Modified Davis grading; NIDEK AFC-230 fundus camera; 45-degree field of view: 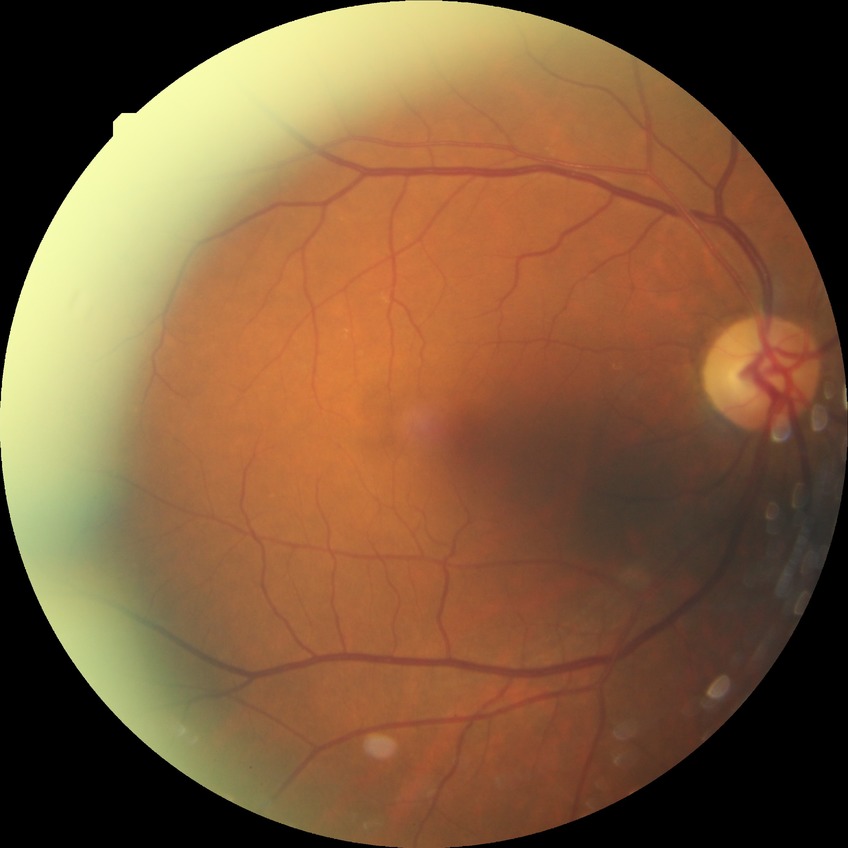
DR severity: NDR.